CFP; FOV: 45 degrees: 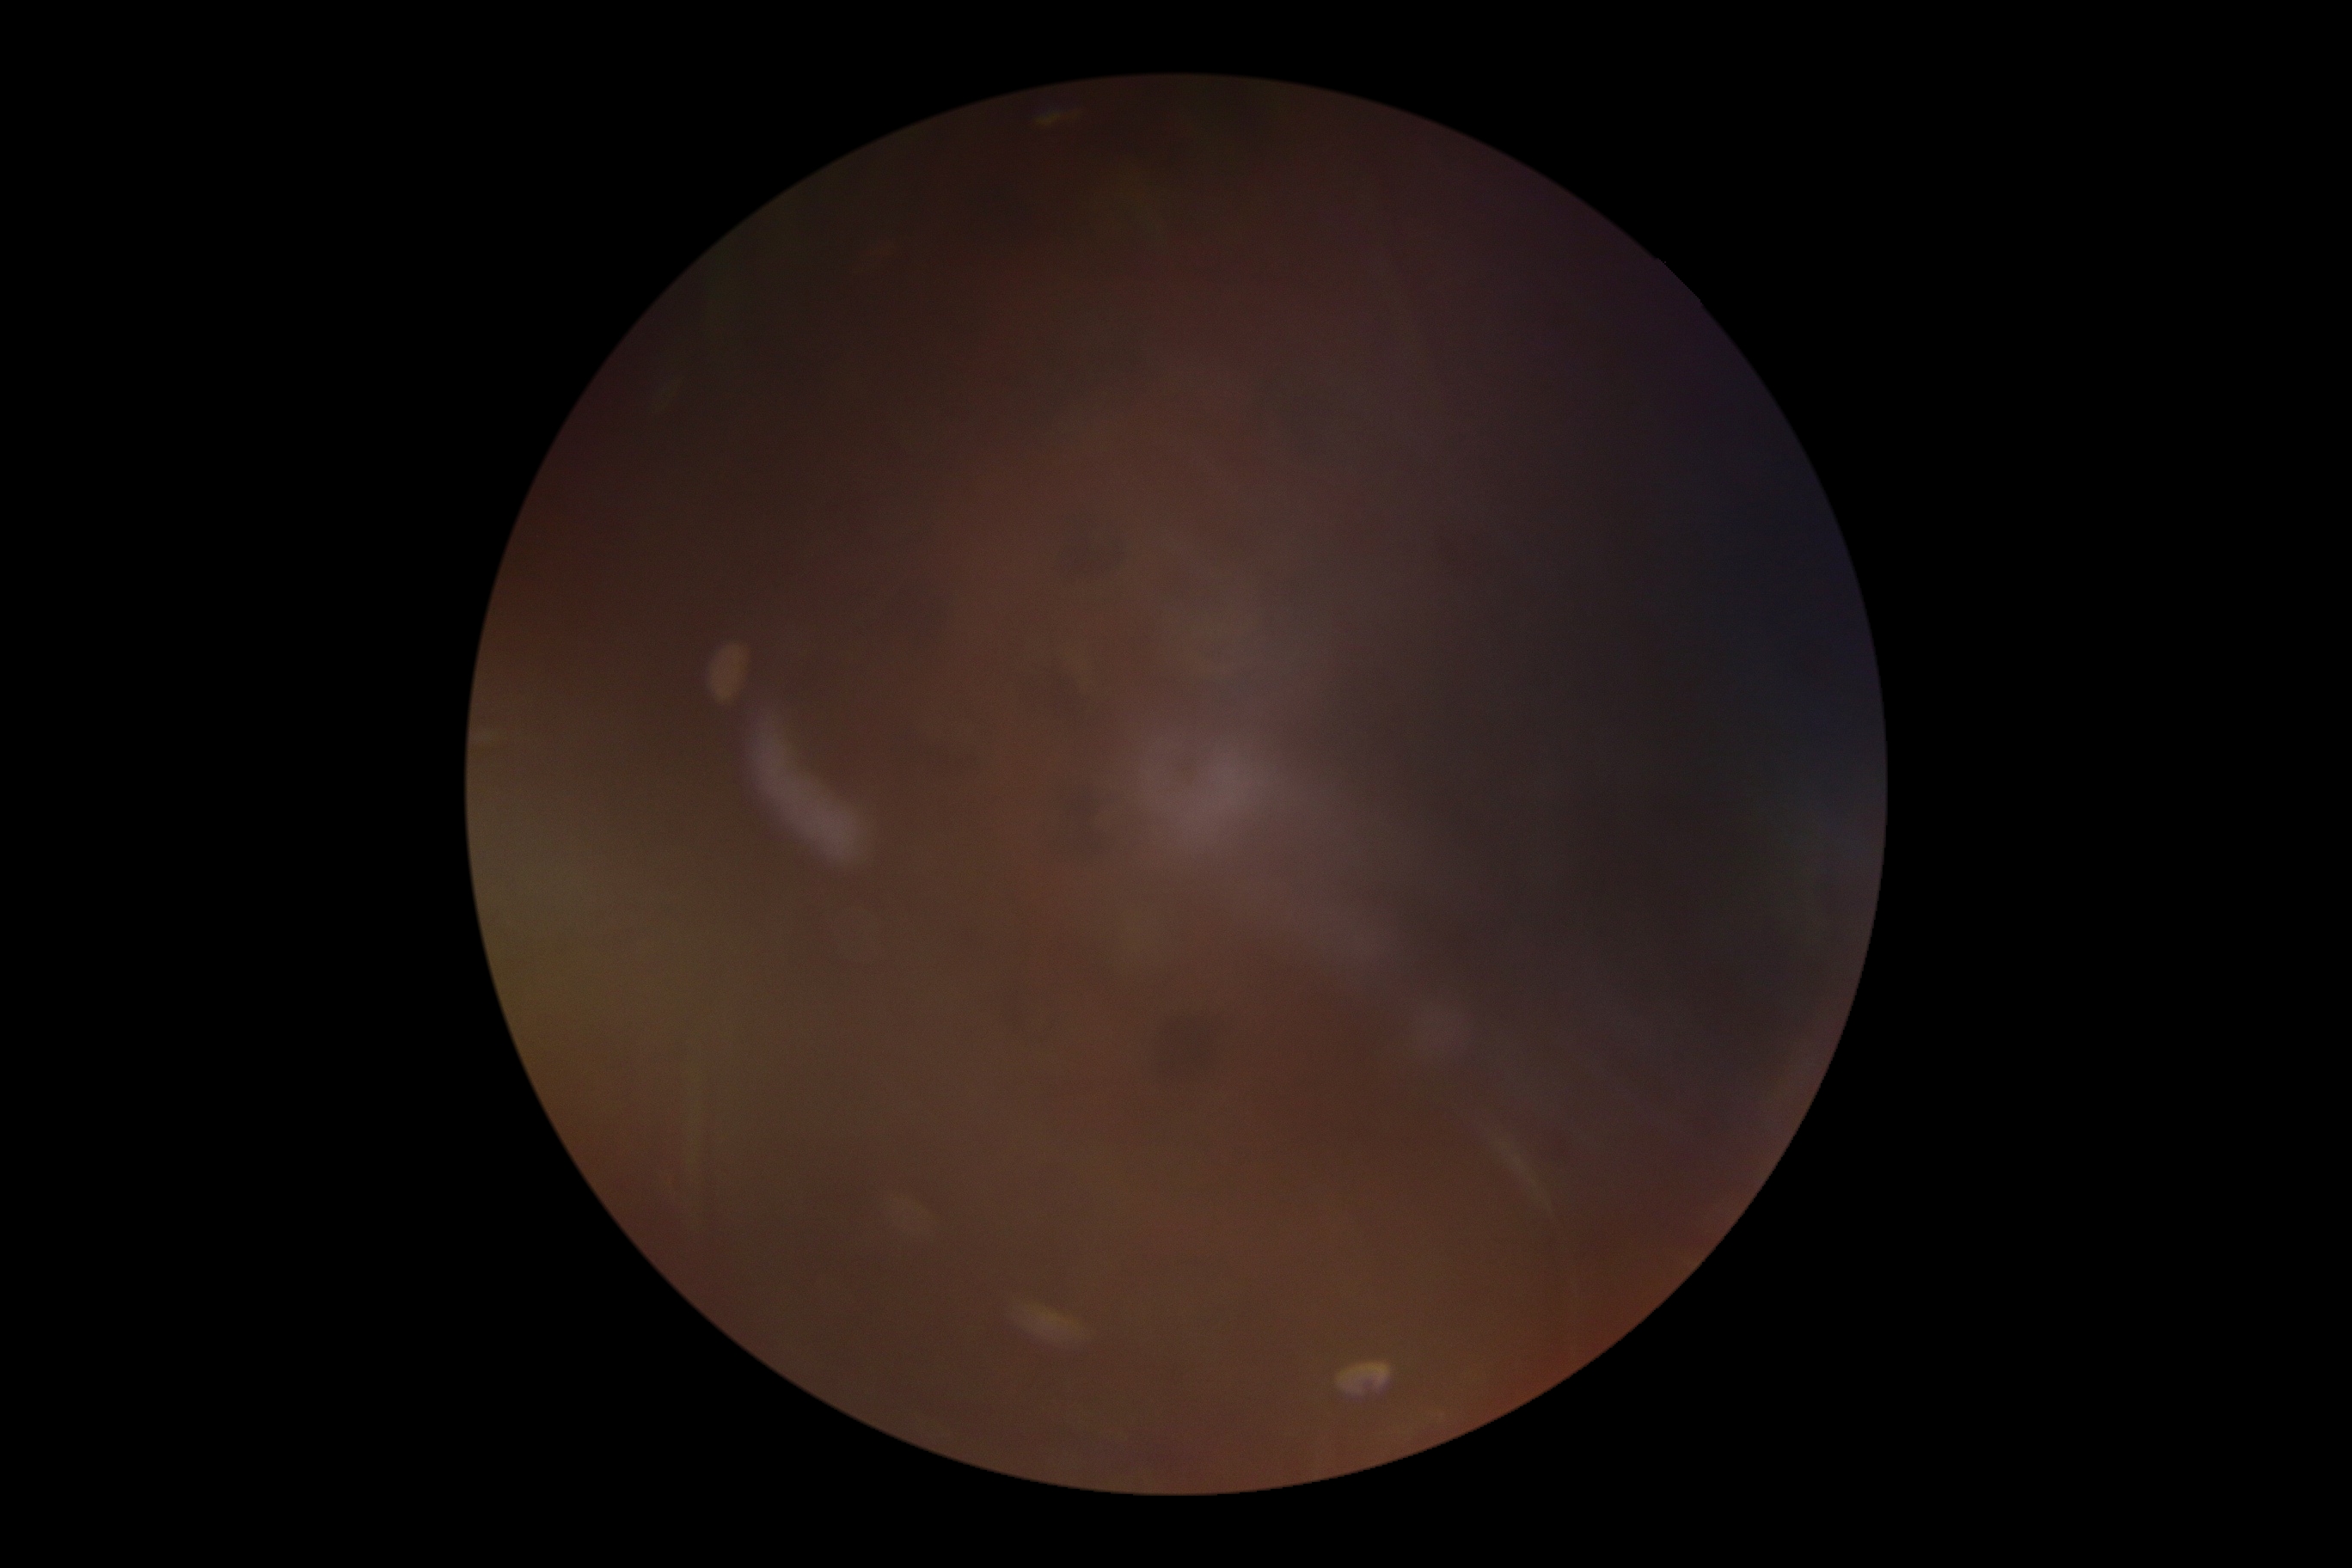
DR stage is ungradable due to poor image quality.